Camera: NIDEK AFC-230: 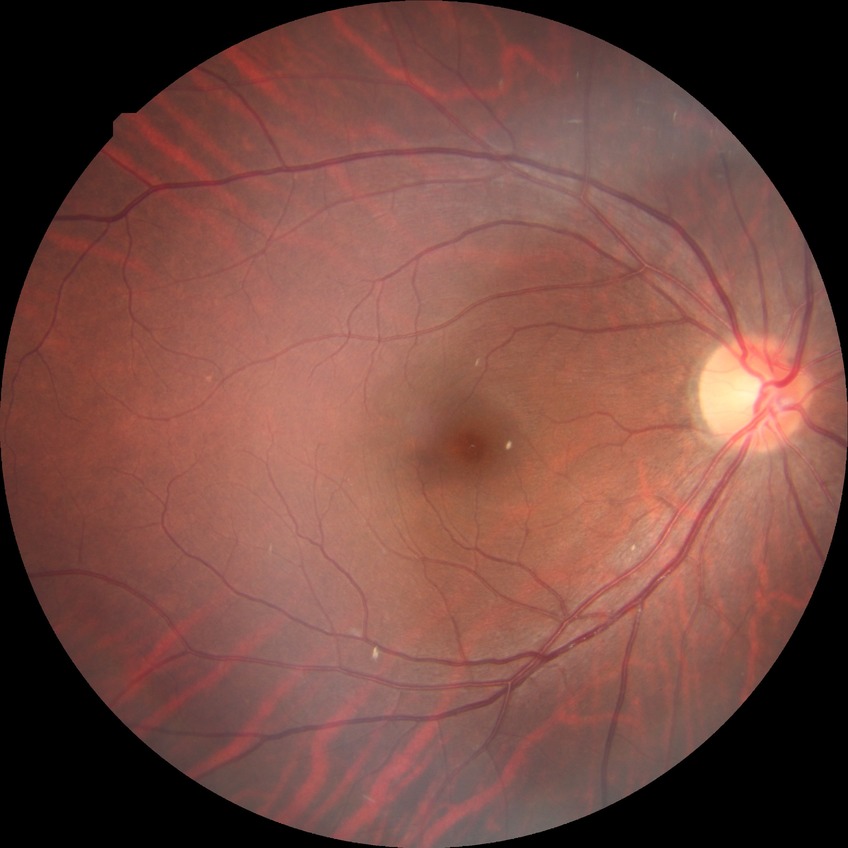

Diabetic retinopathy severity: no diabetic retinopathy.